CFP; 2352 x 1568 pixels
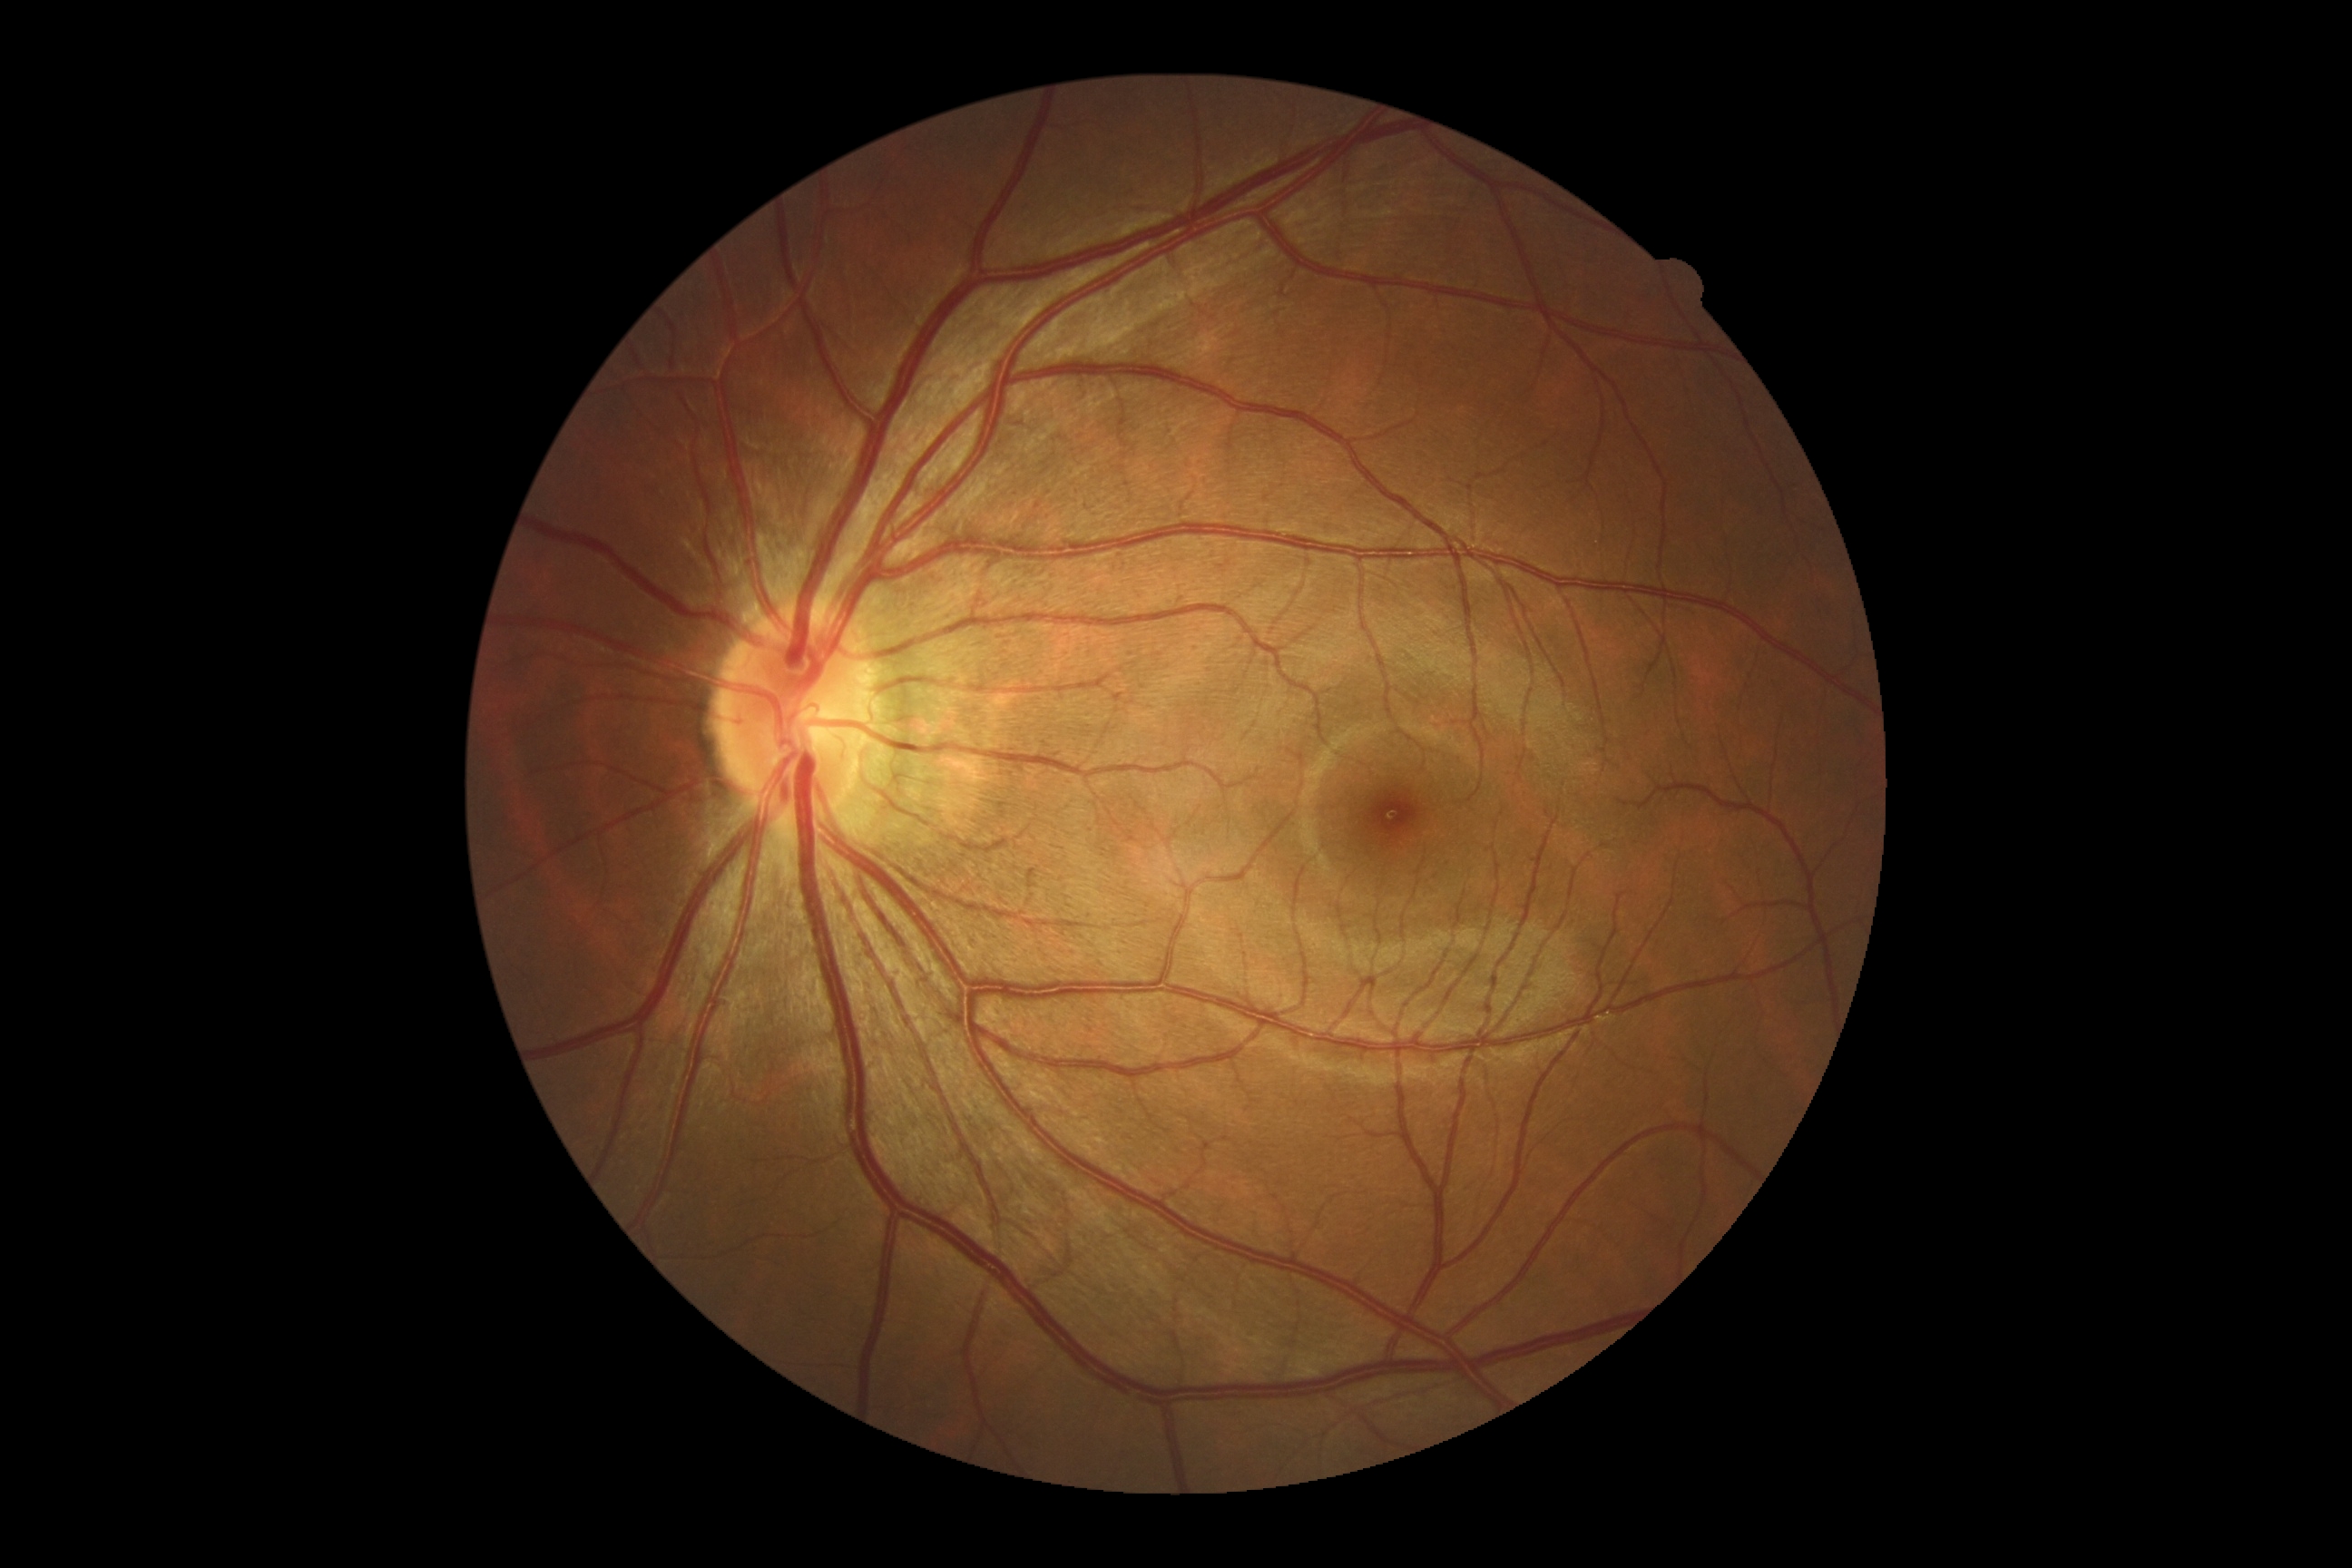
DR stage is grade 0.